2352x1568px
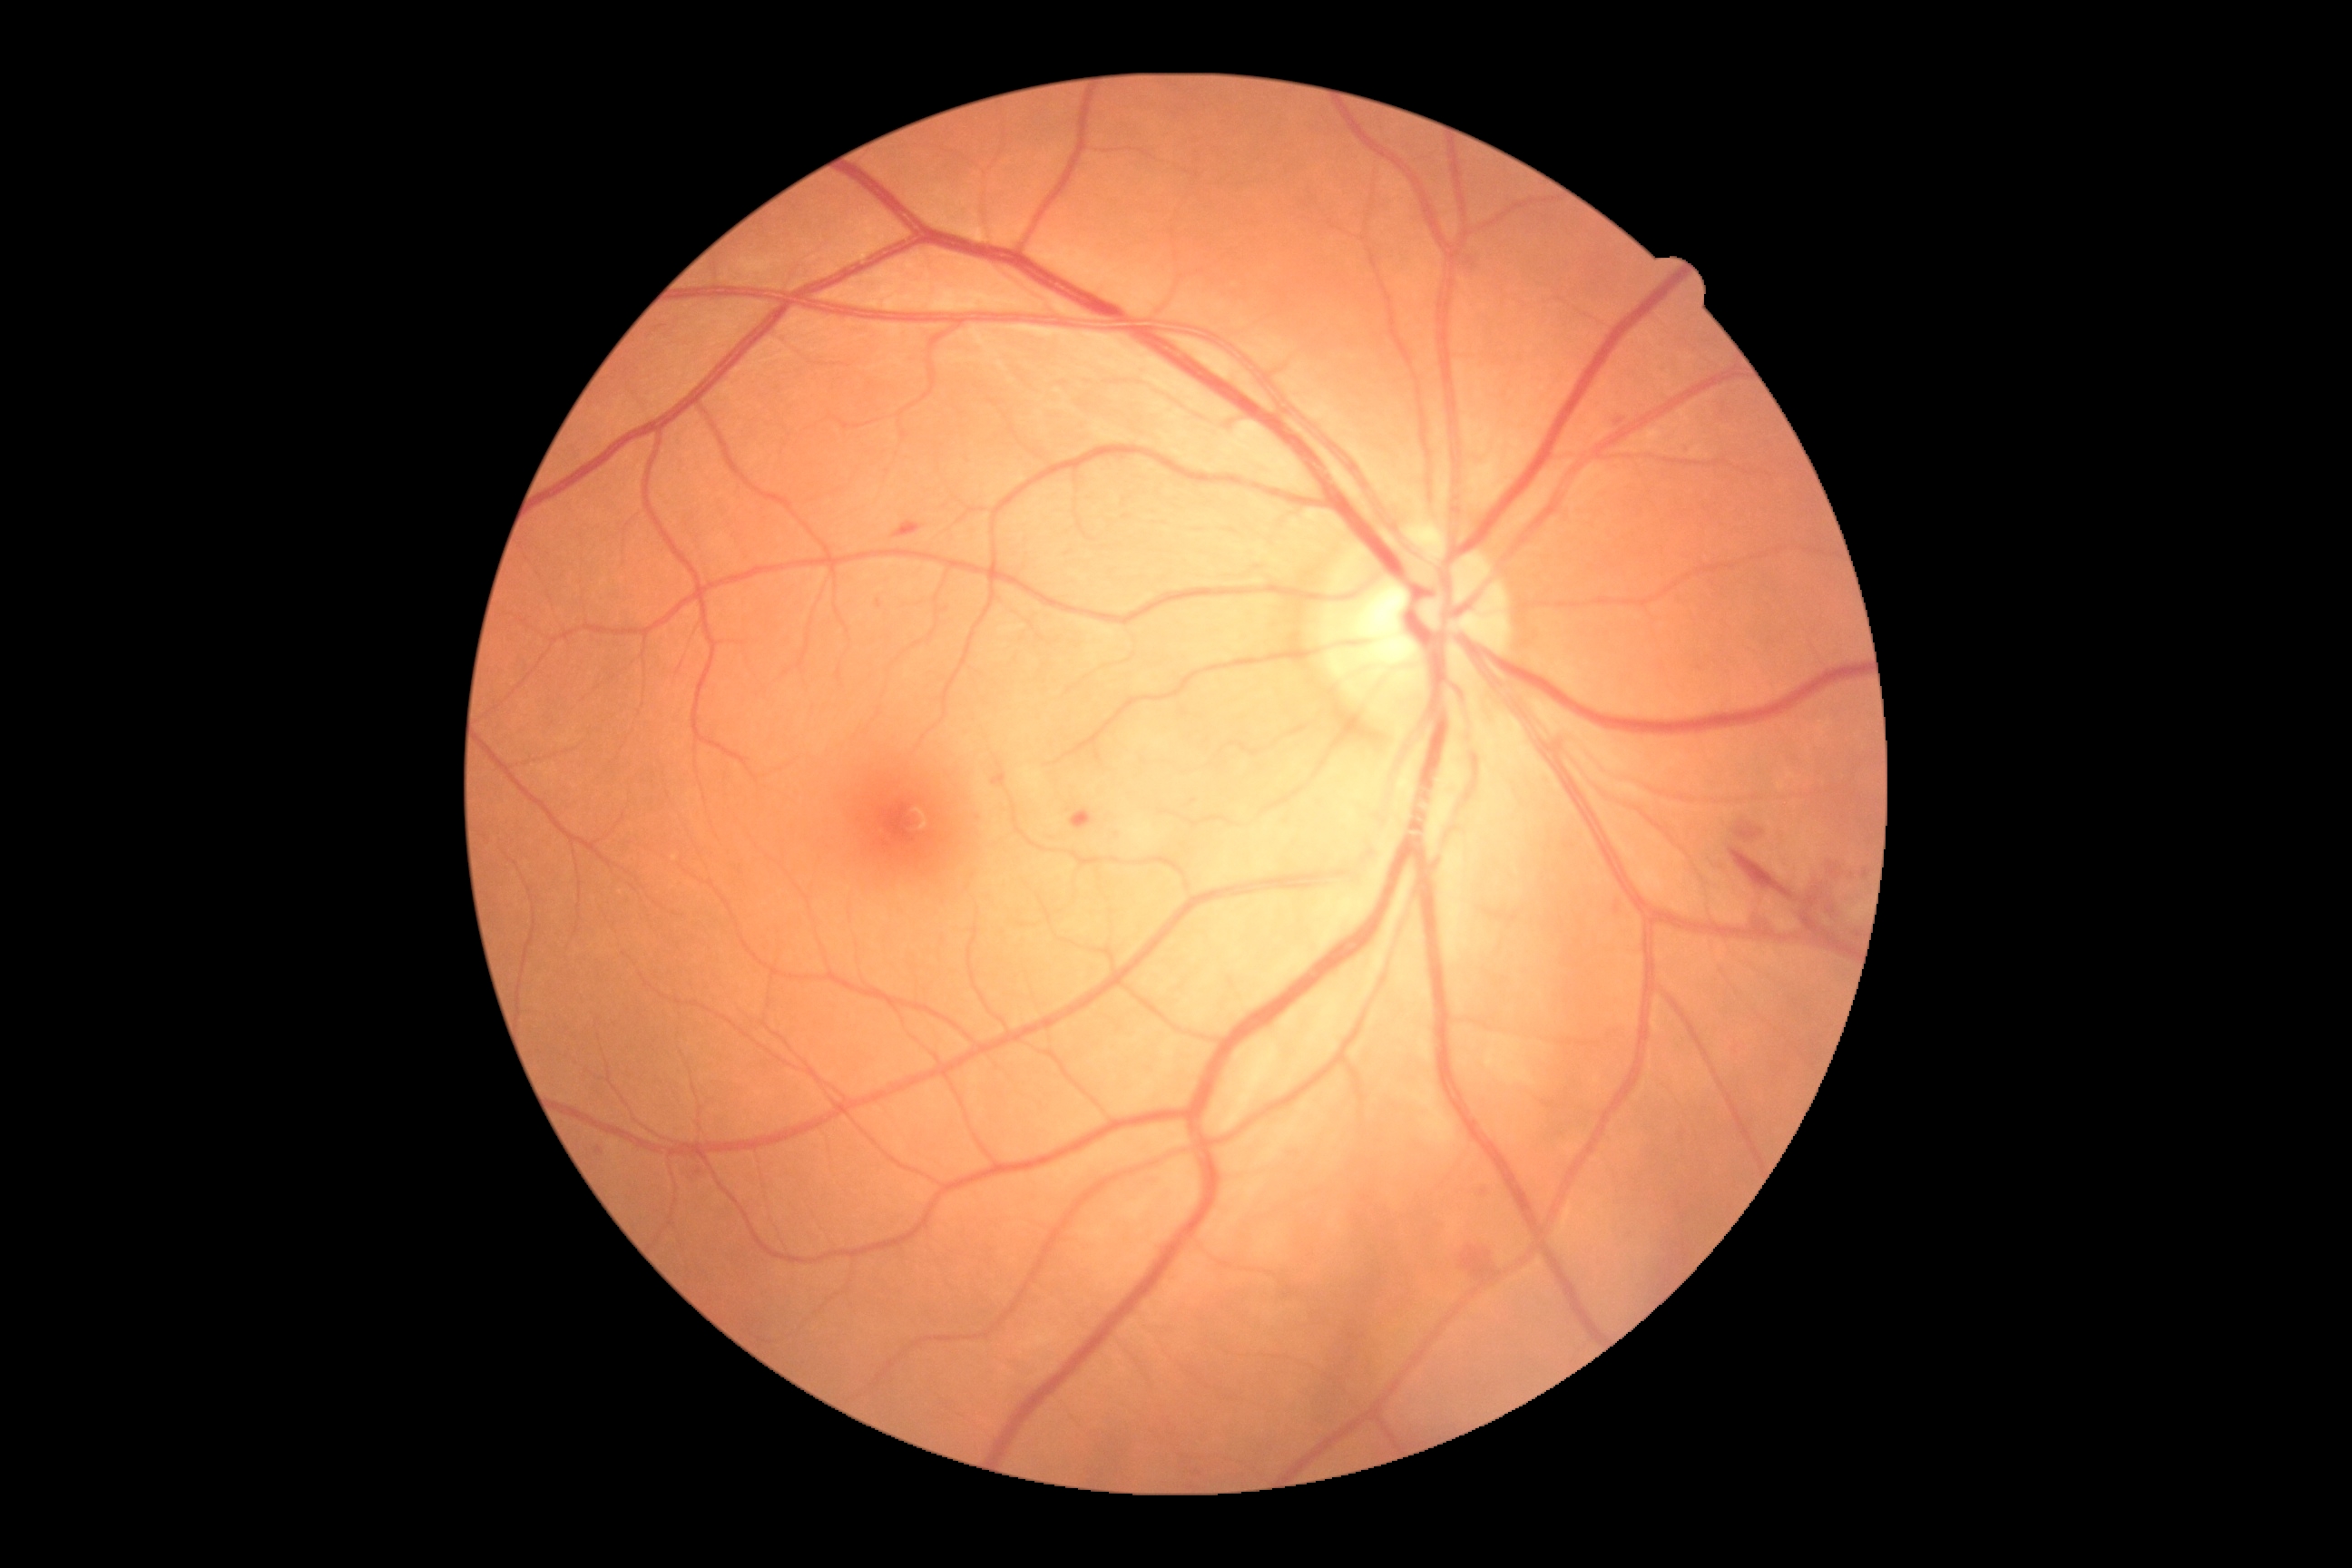 Diabetic retinopathy (DR): 2 — more than just microaneurysms but less than severe NPDR.